Pediatric retinal photograph (wide-field) — 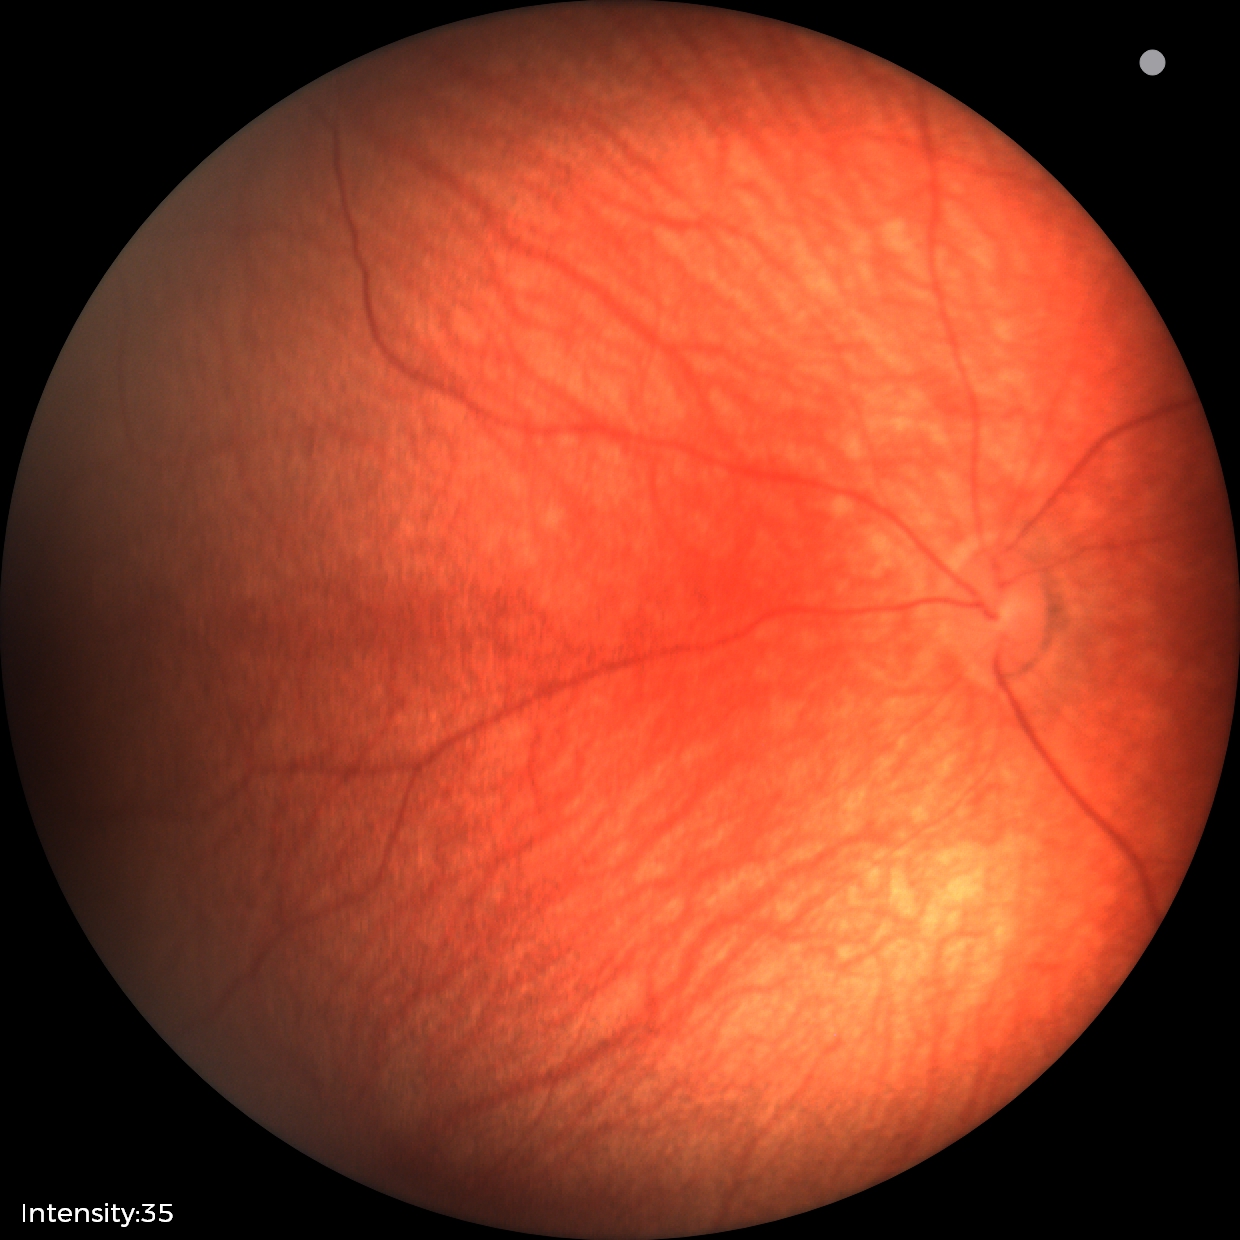

Screening series with retinal hemorrhages.